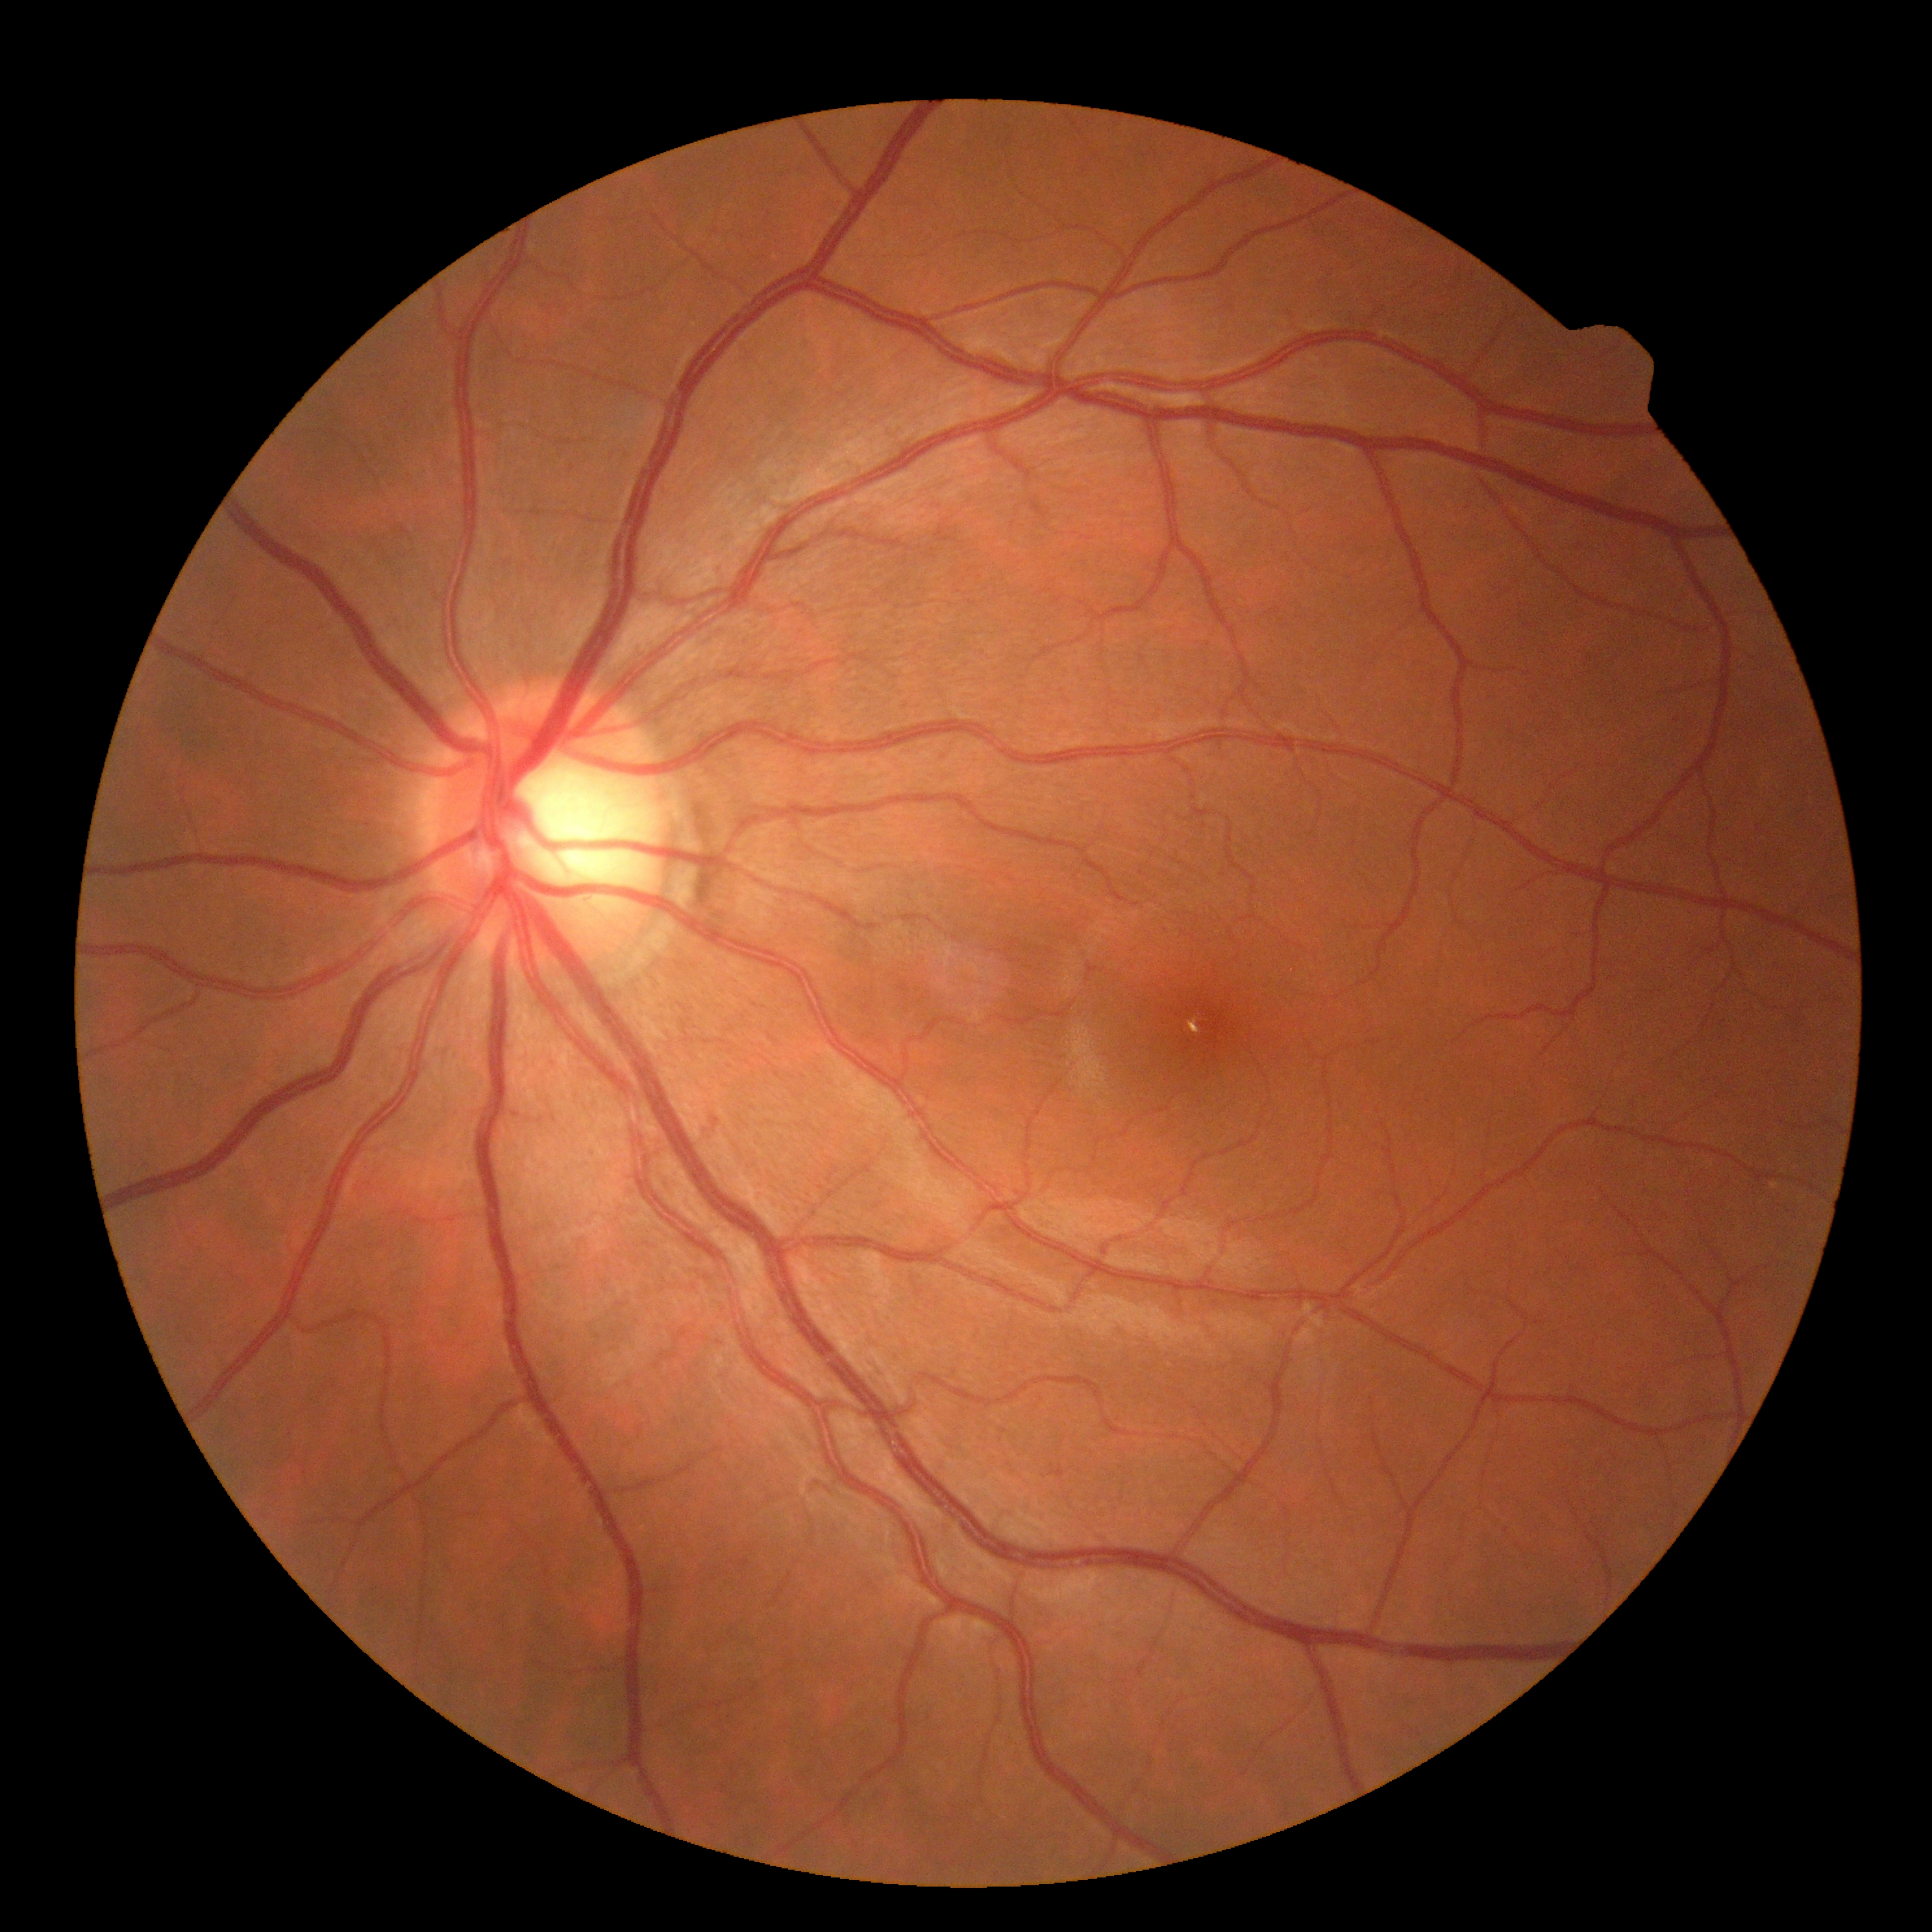

DR grade is 0 (no apparent retinopathy).